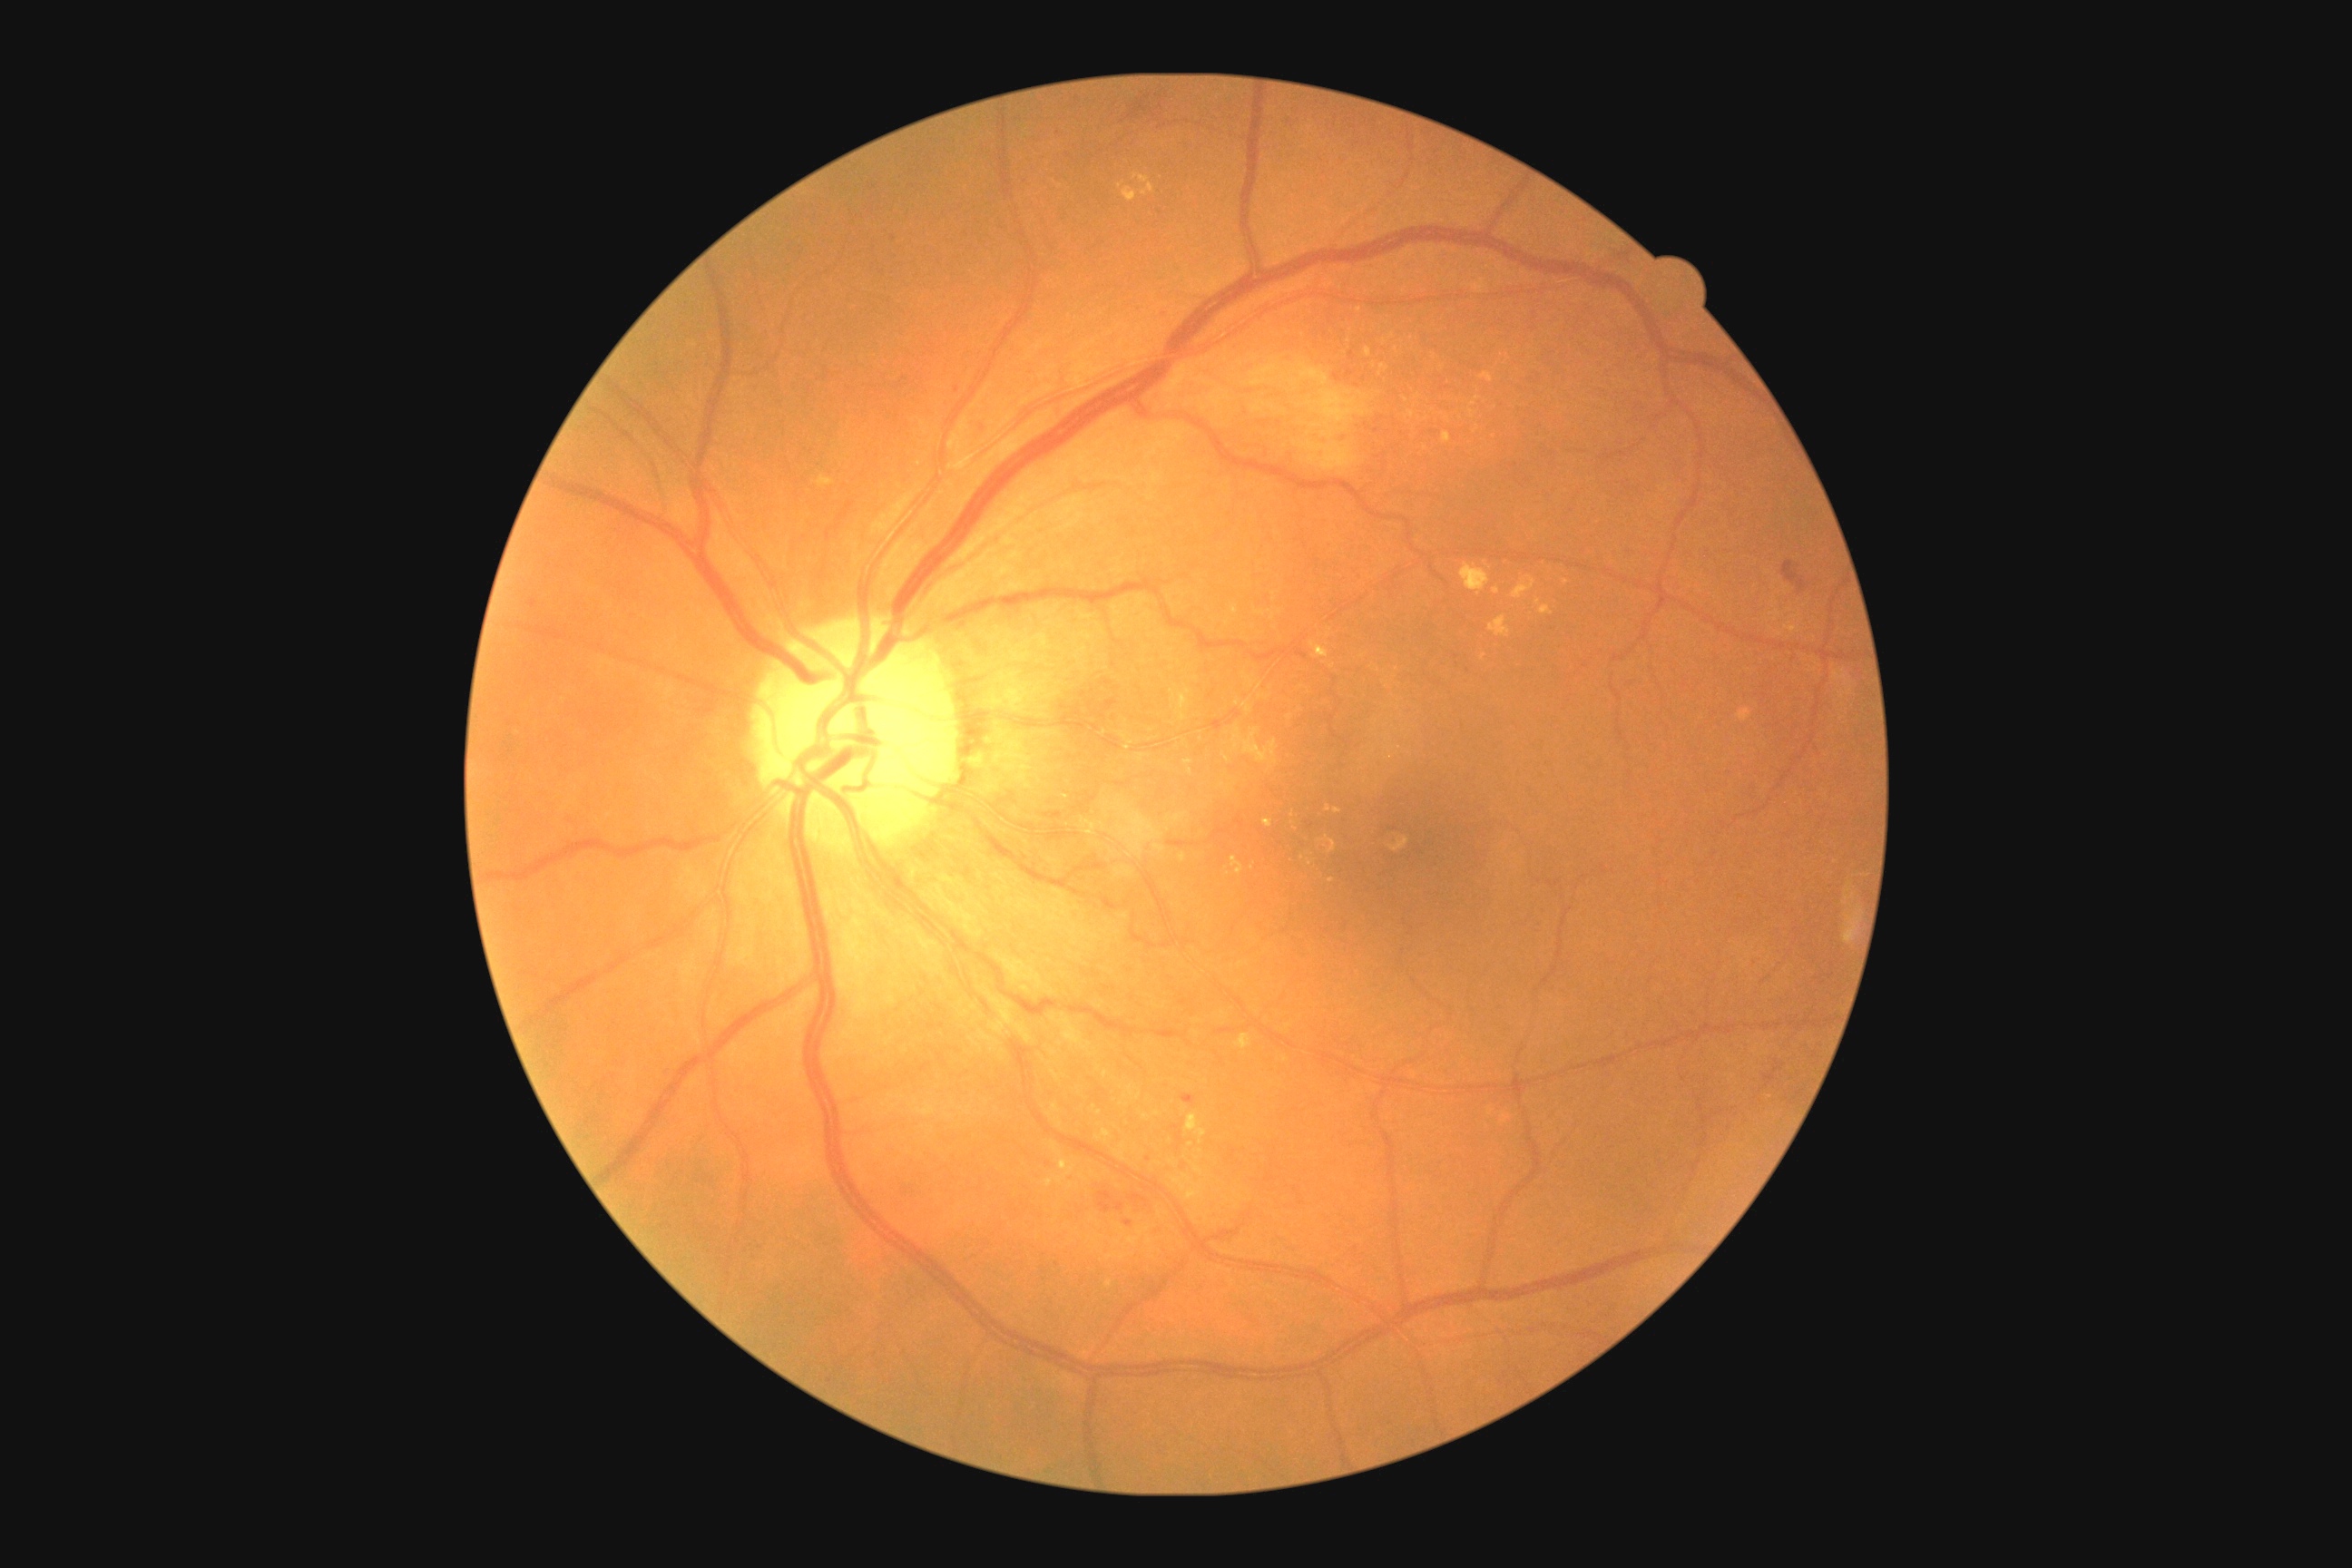 DR class=non-proliferative diabetic retinopathy; diabetic retinopathy grade=2.